Tabletop color fundus camera image.
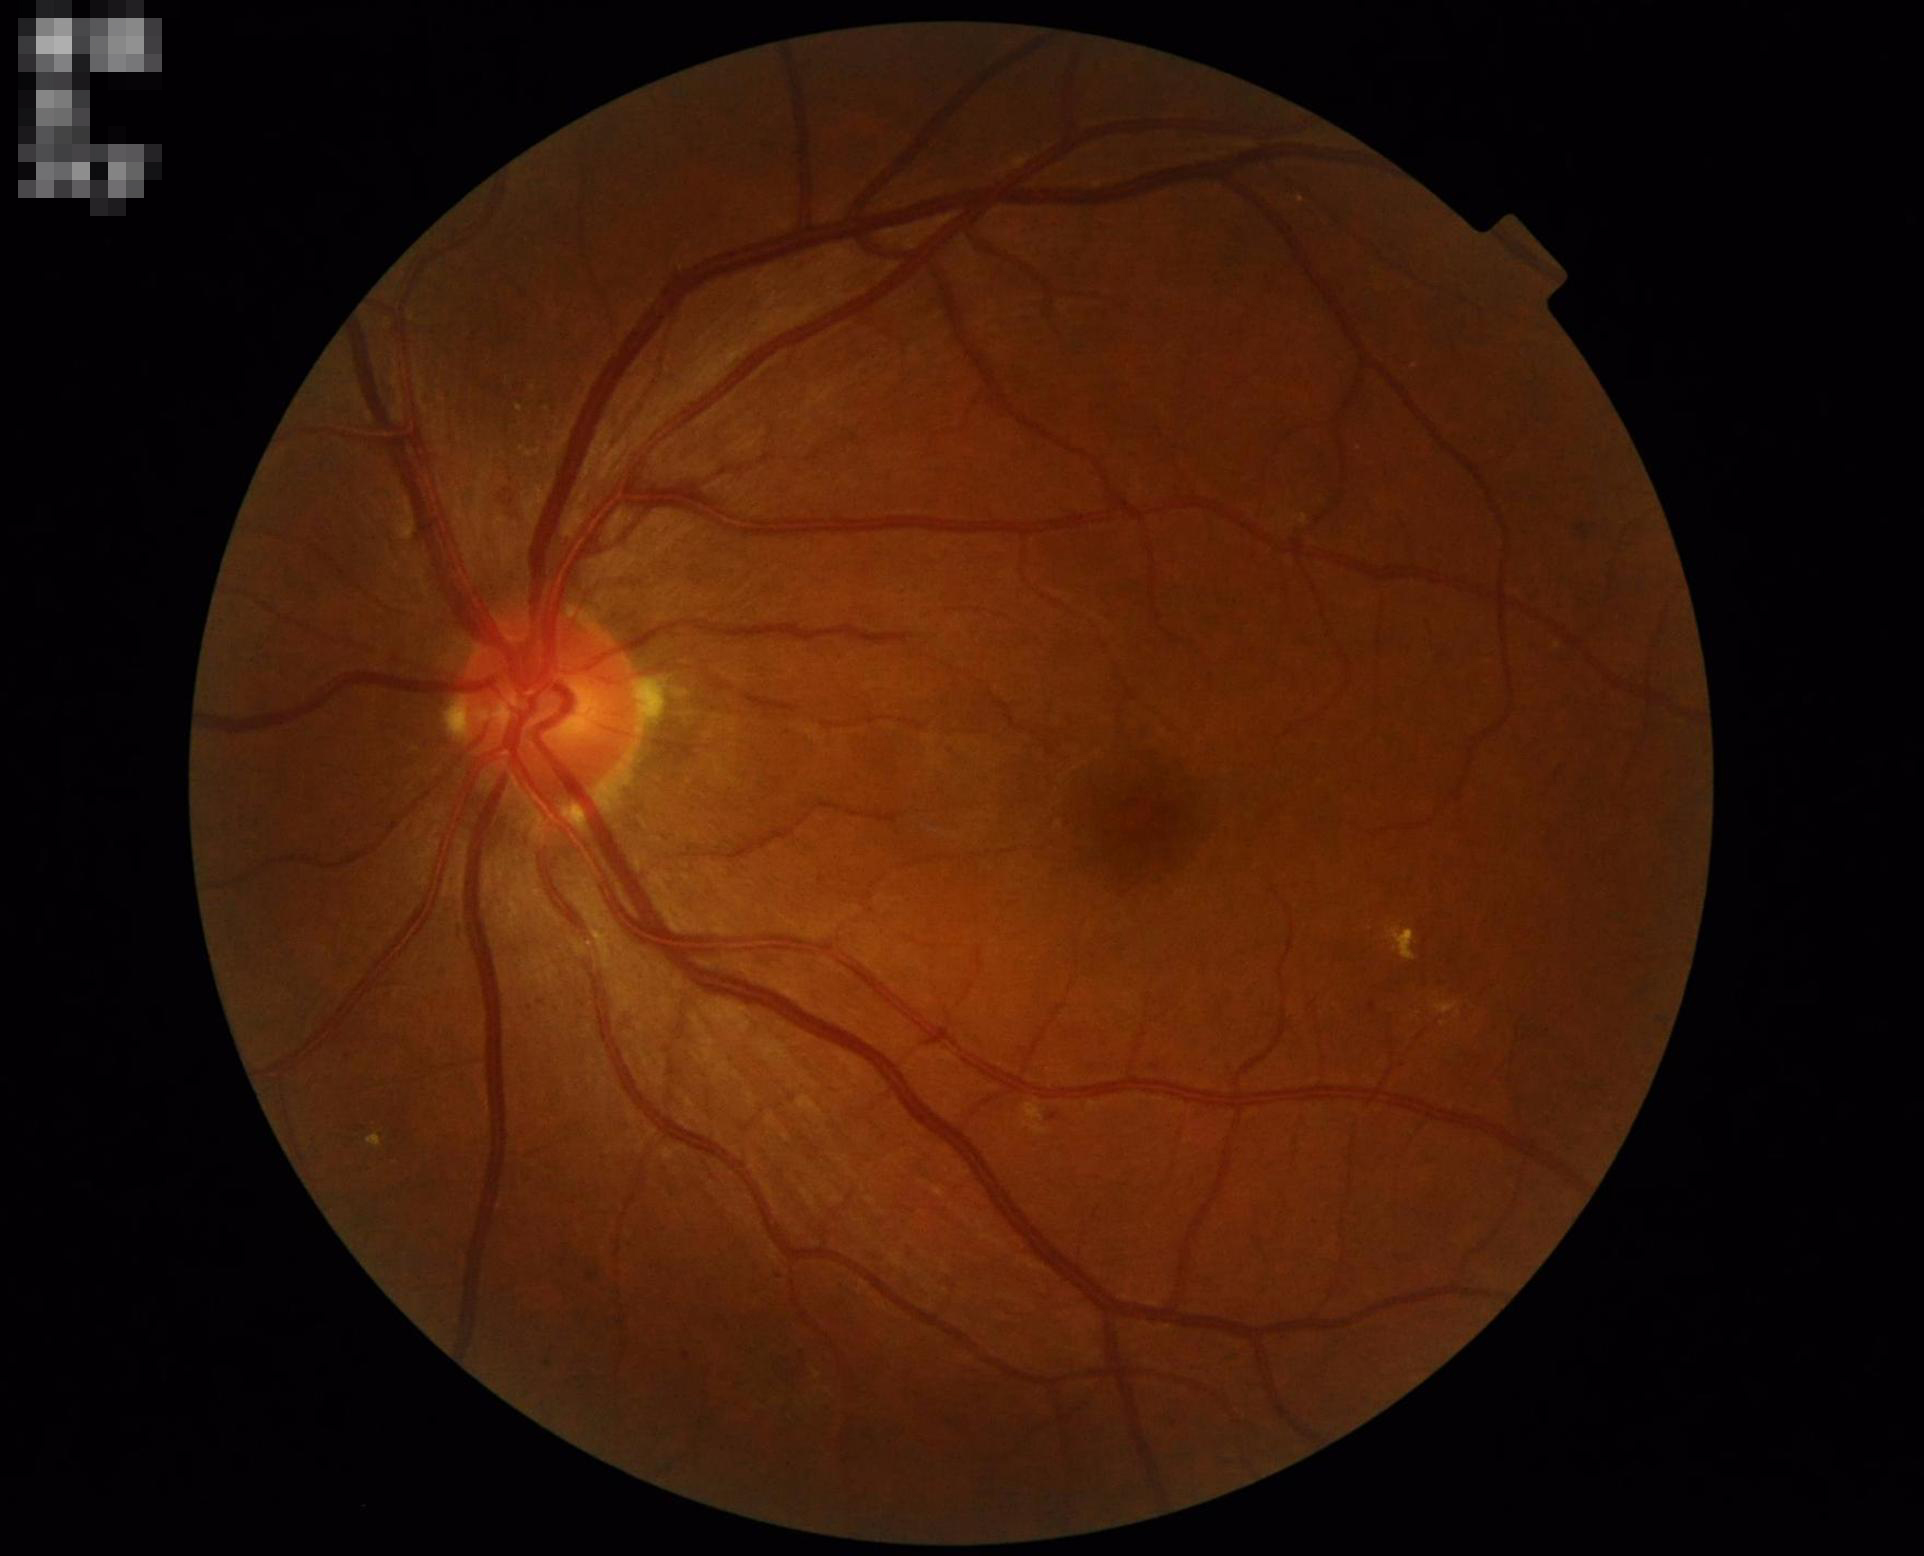 {"illumination": "adequate", "clarity": "in focus", "overall_quality": "adequate"}